CFP; 2352x1568px; FOV: 45 degrees.
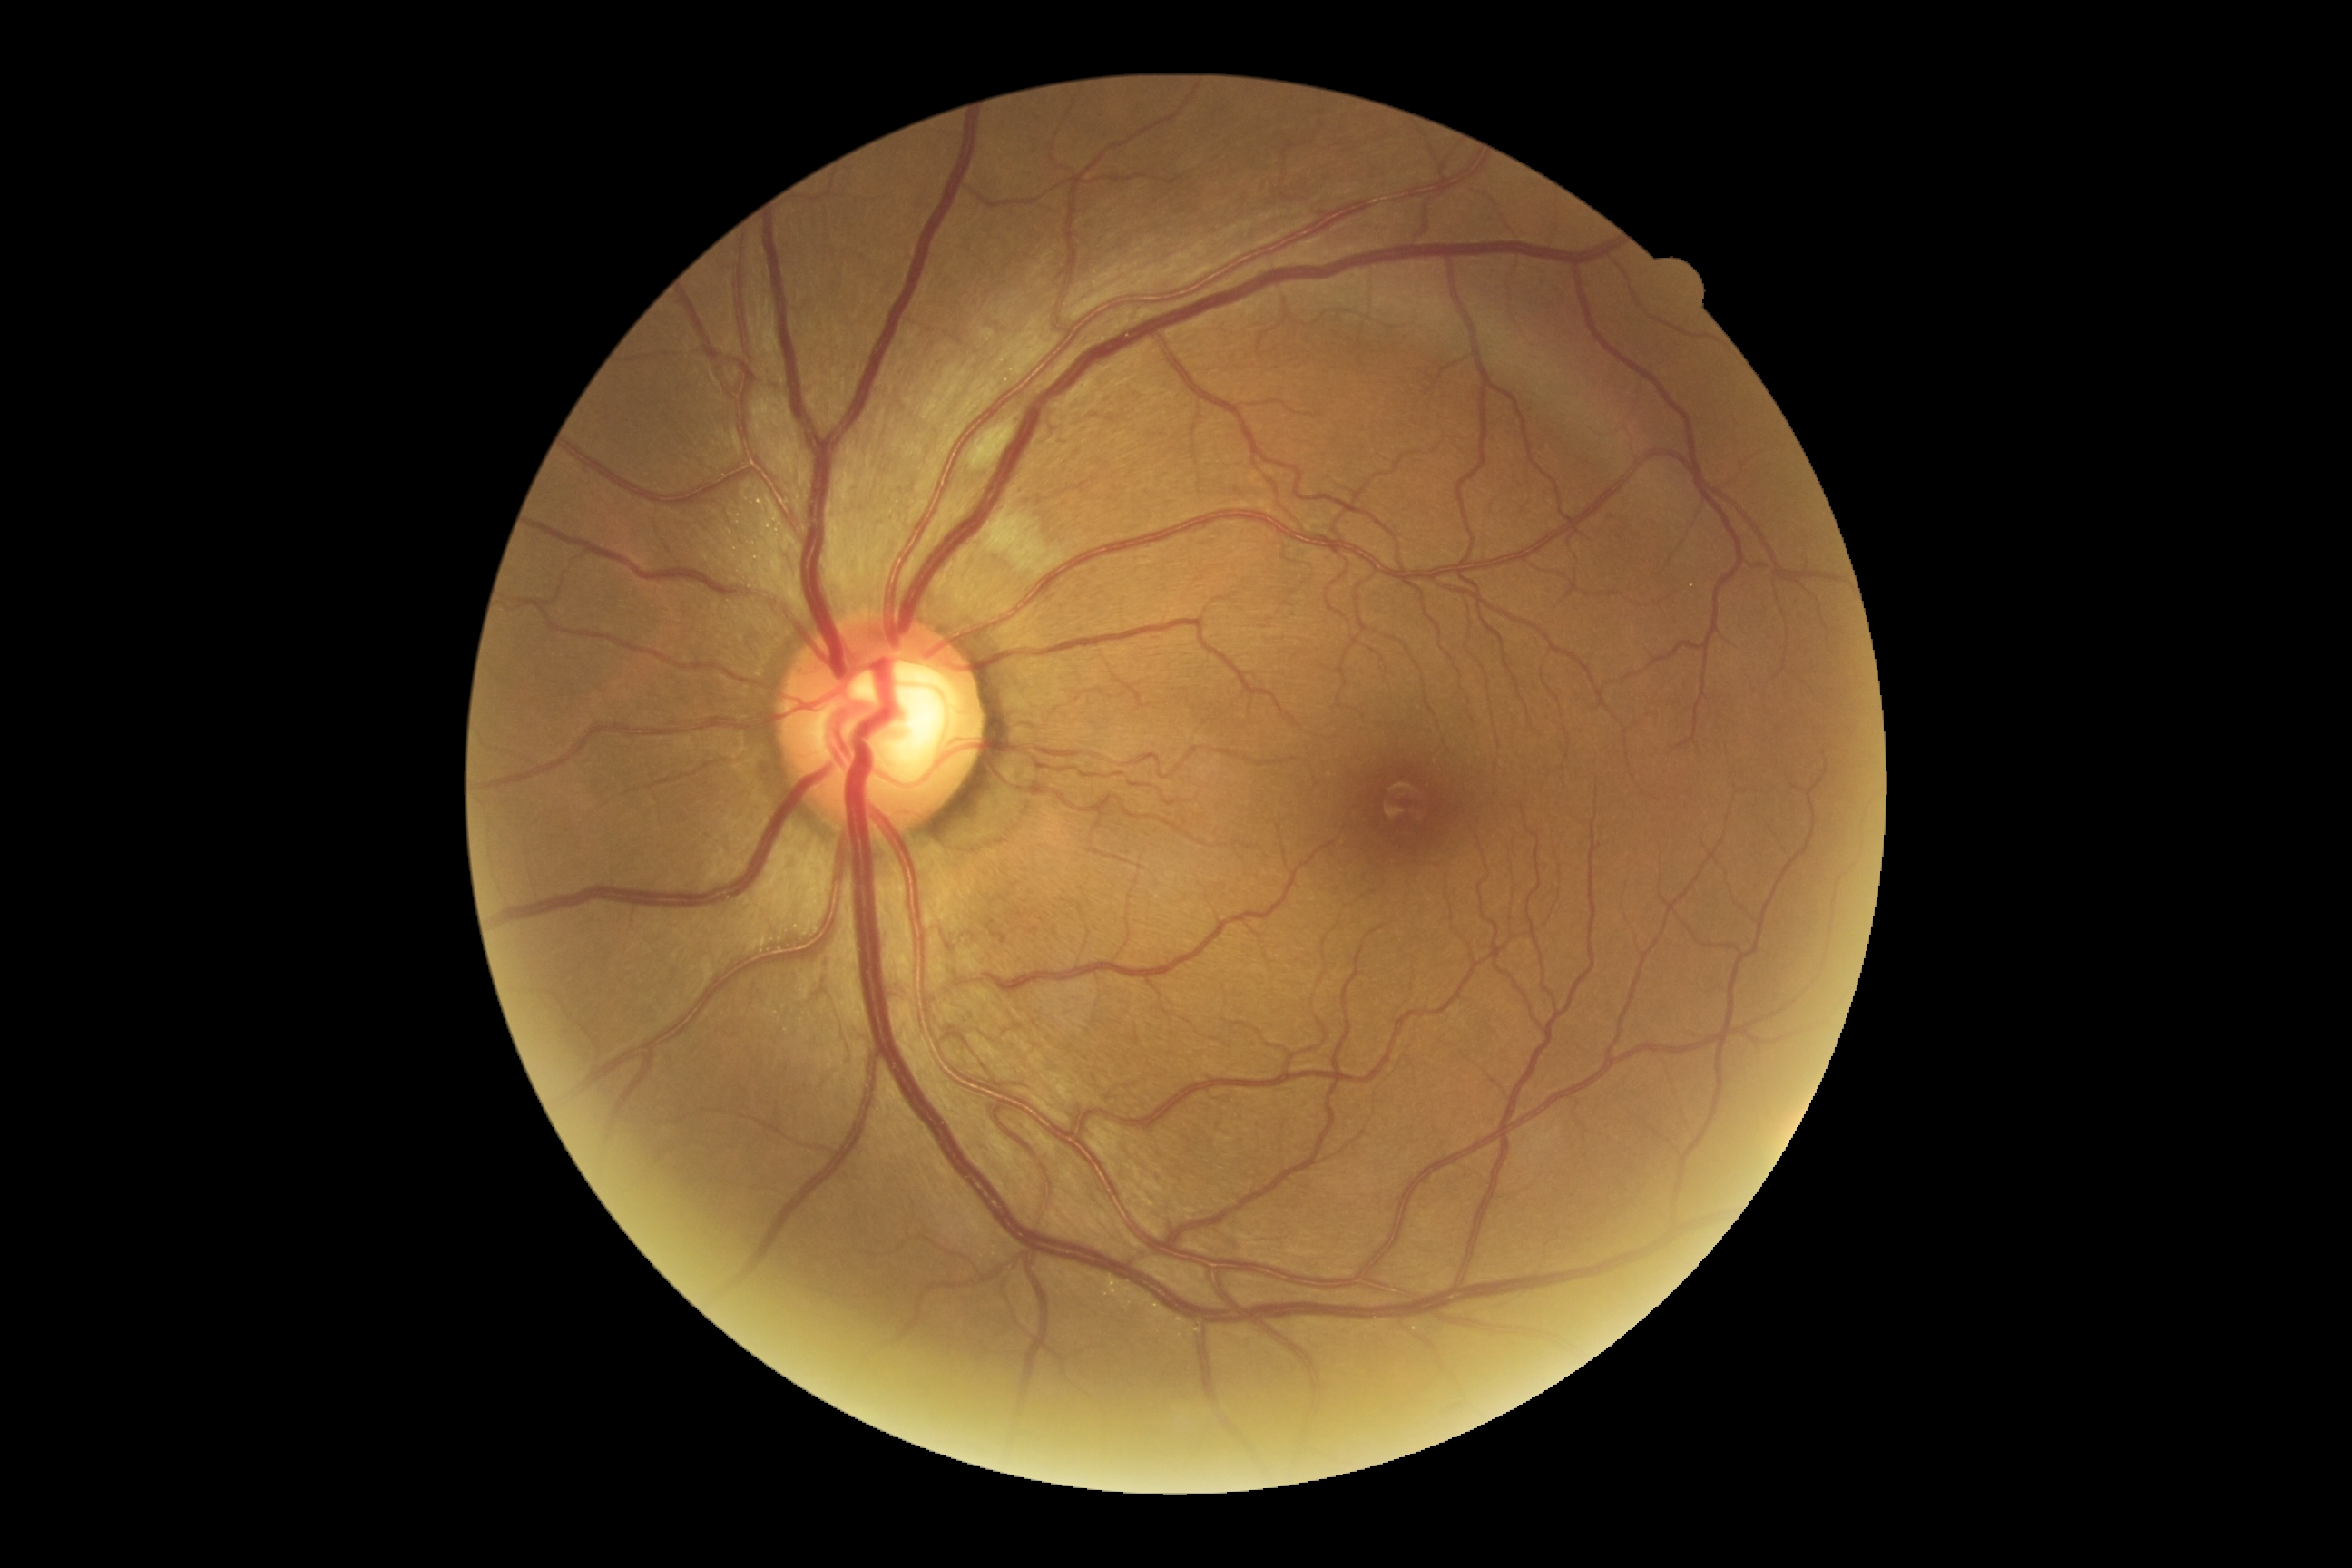
diabetic retinopathy = 2/4.